Without pupil dilation, 45° field of view, 848 by 848 pixels, fundus photo.
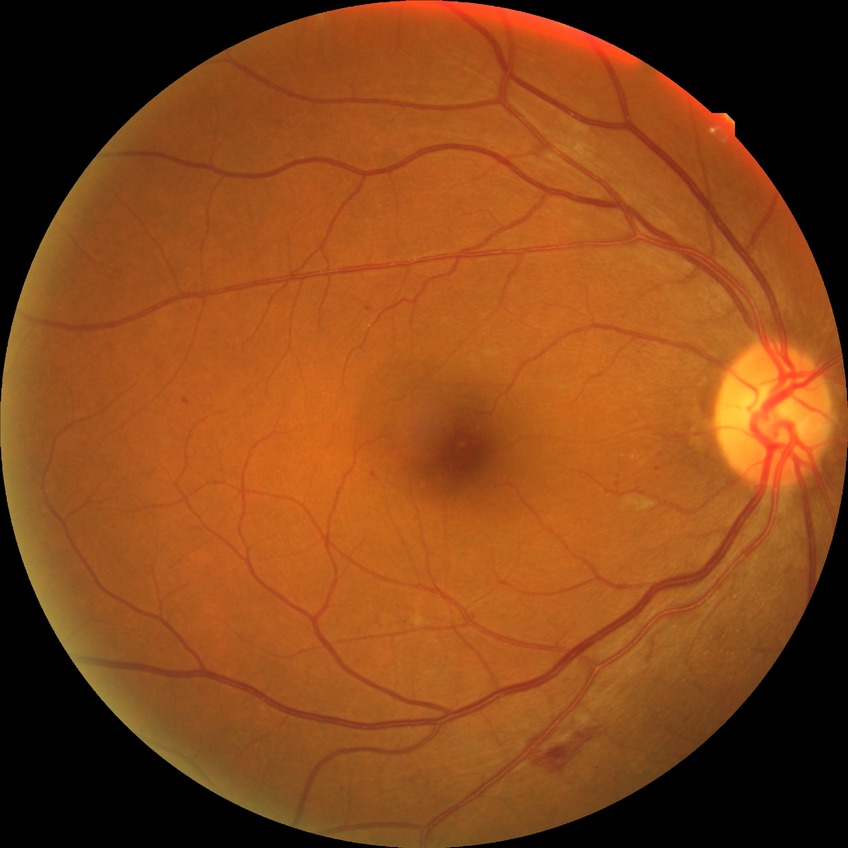 diabetic retinopathy (DR) = simple diabetic retinopathy (SDR); DR class = non-proliferative diabetic retinopathy.